848 by 848 pixels: 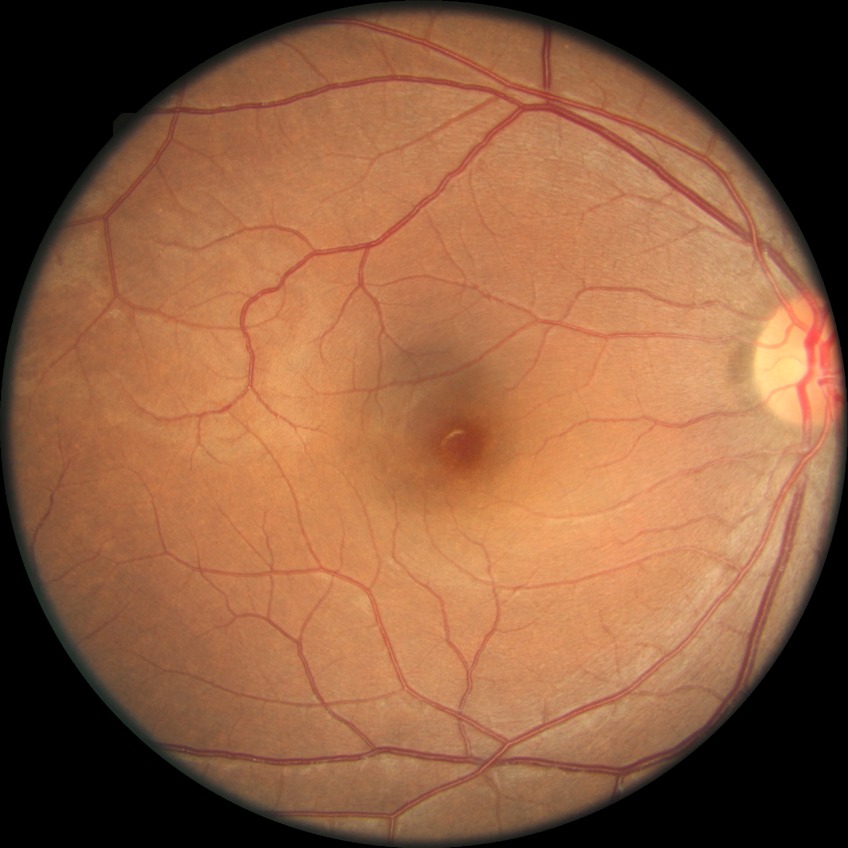 * diabetic retinopathy (DR) — no diabetic retinopathy (NDR)